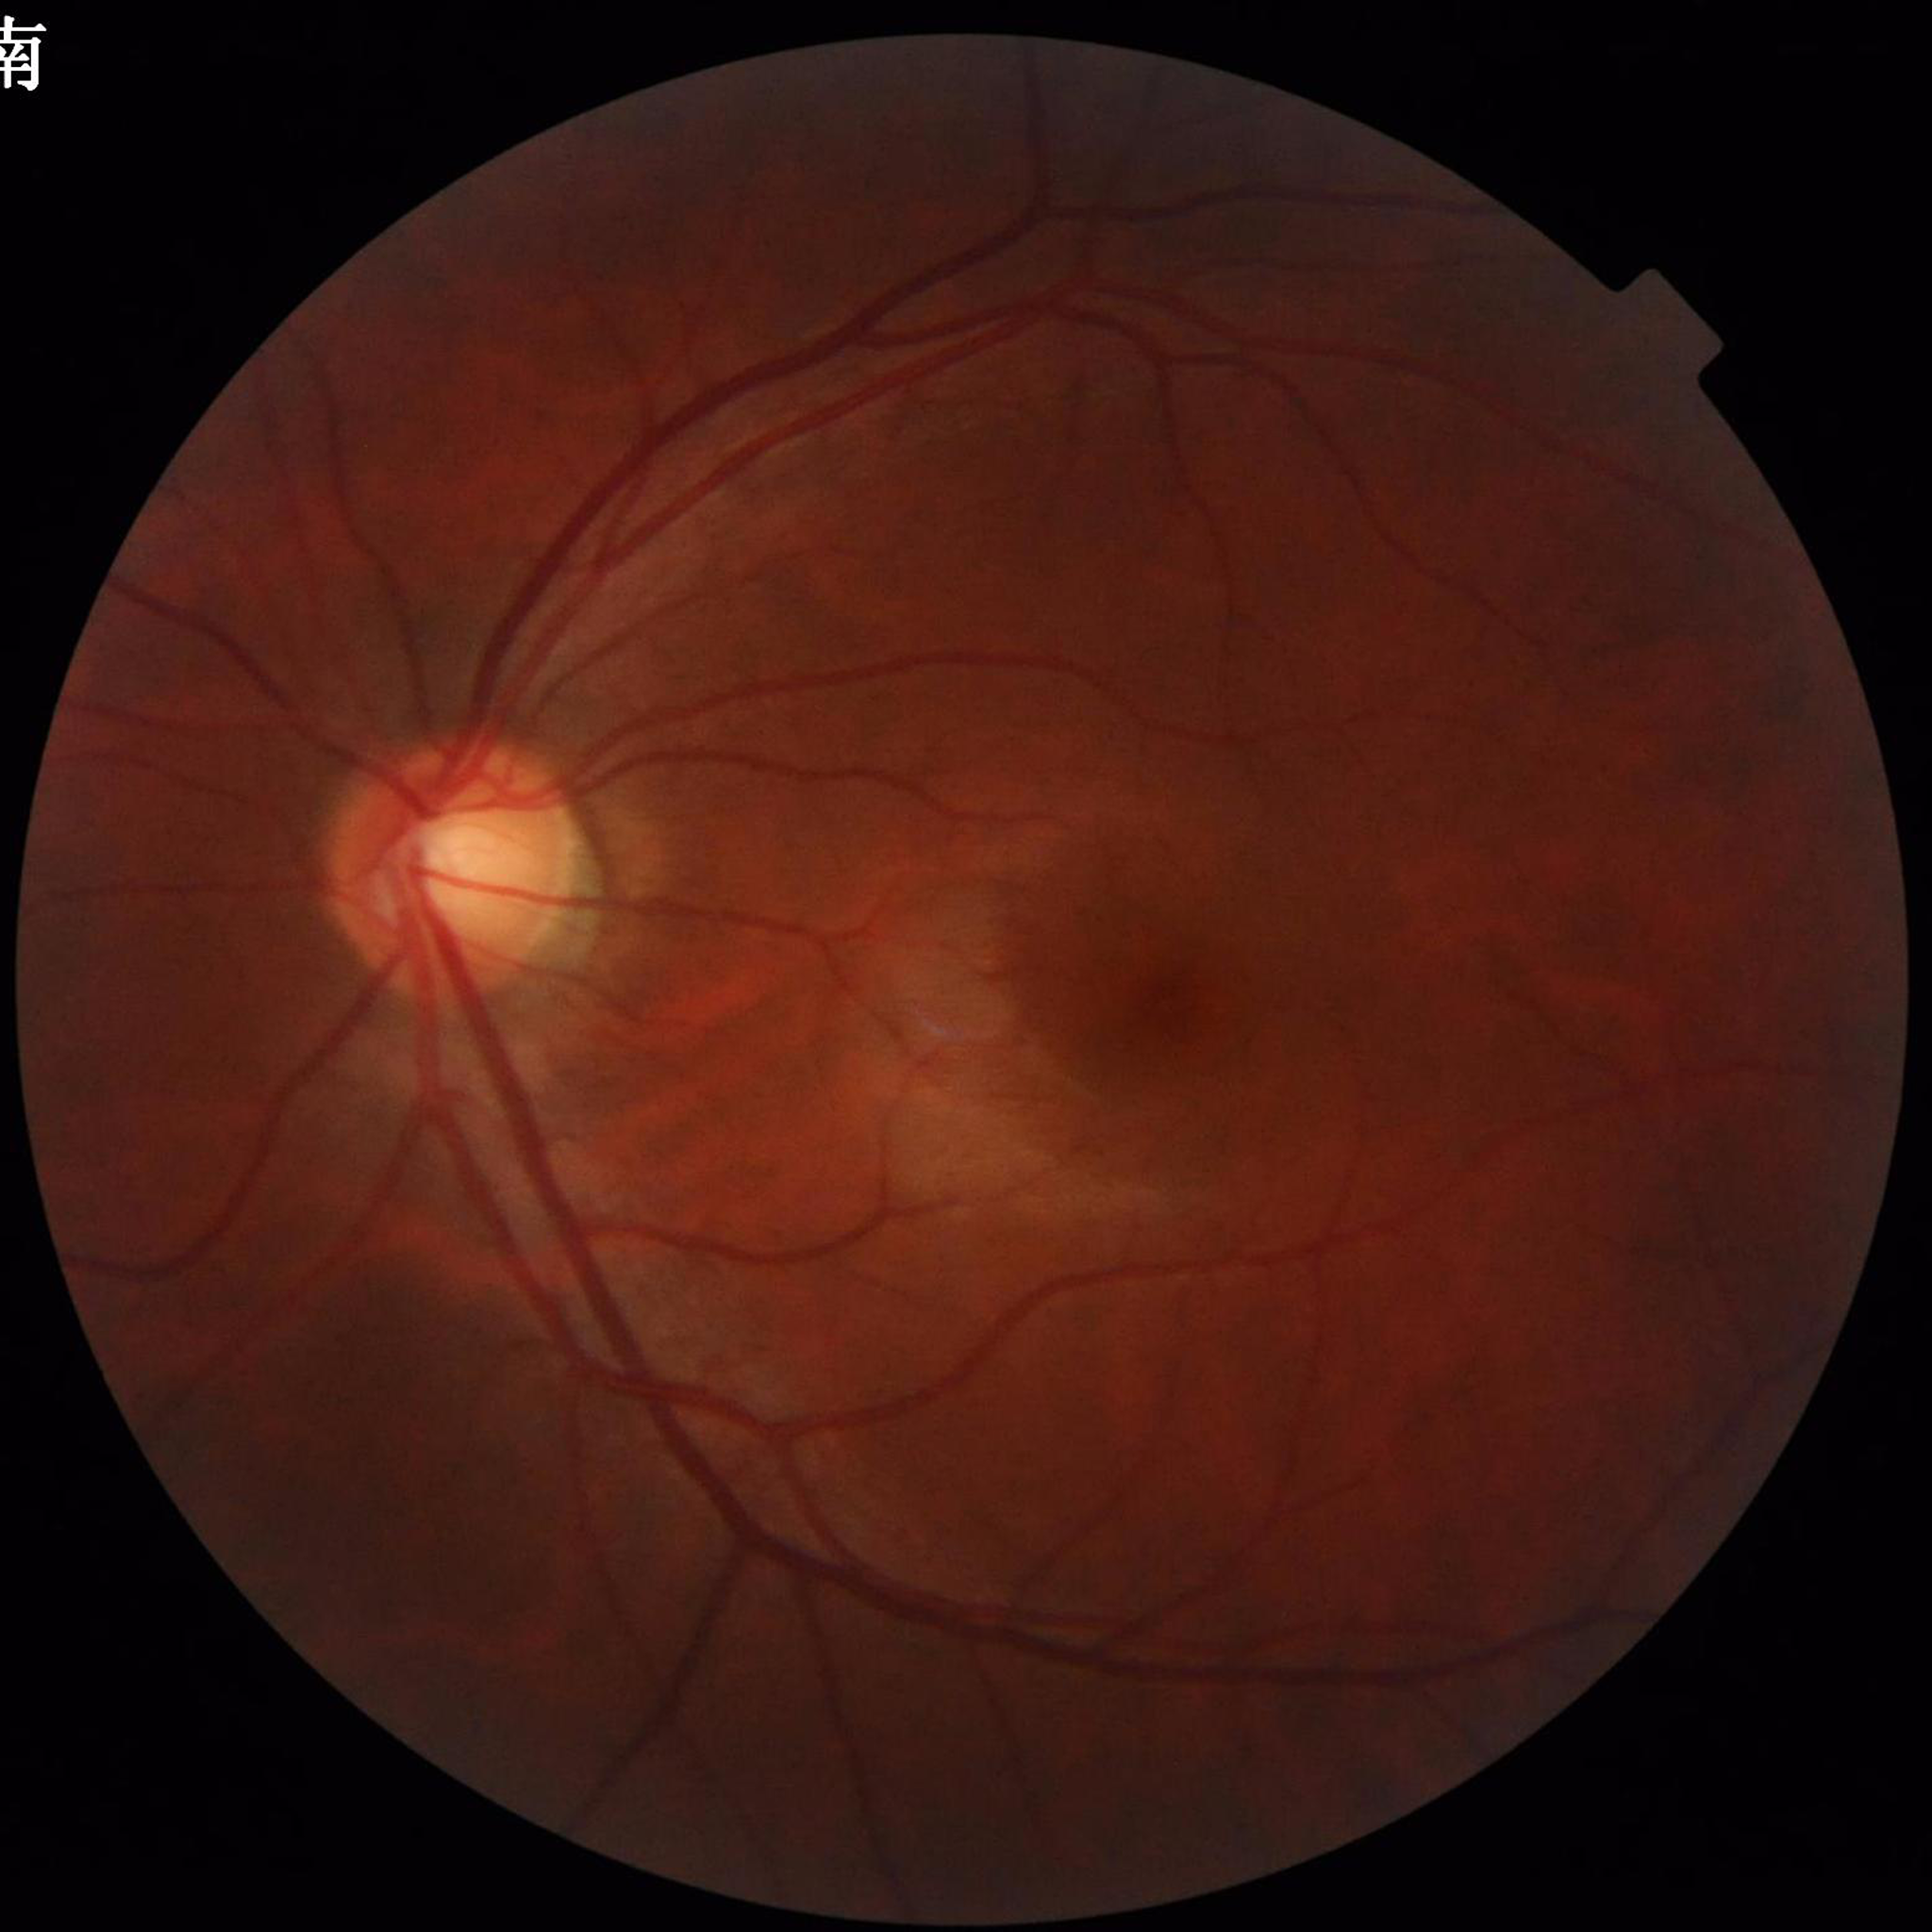

Impression: glaucoma | Quality assessment: good.